Diabetic retinopathy graded by the modified Davis classification — 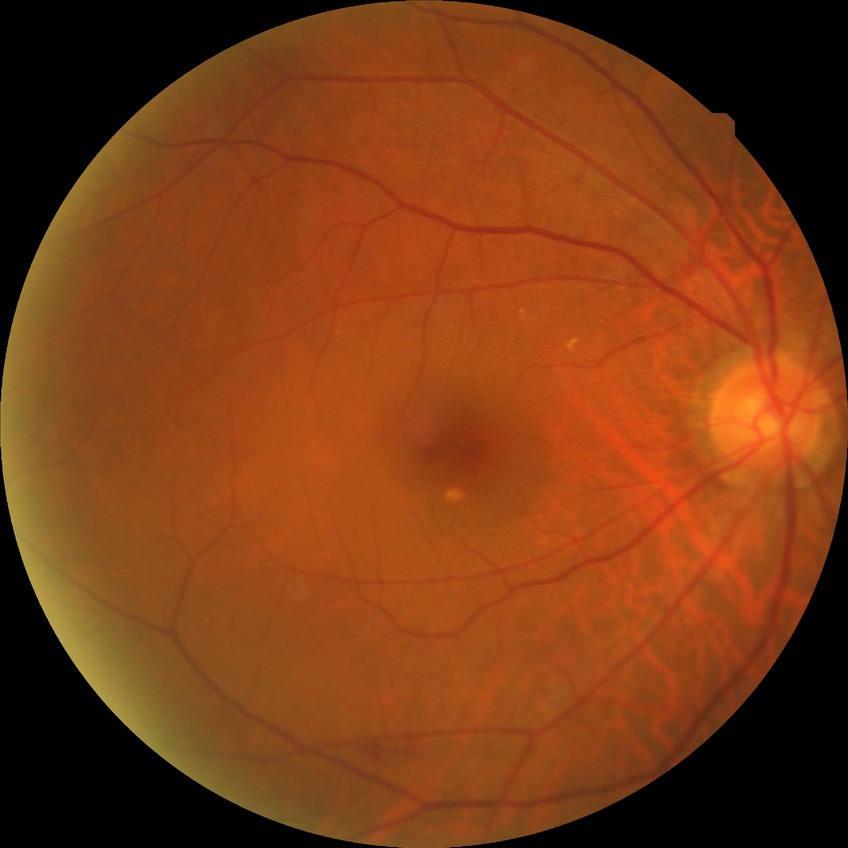

Diabetic retinopathy (DR) is no diabetic retinopathy (NDR).